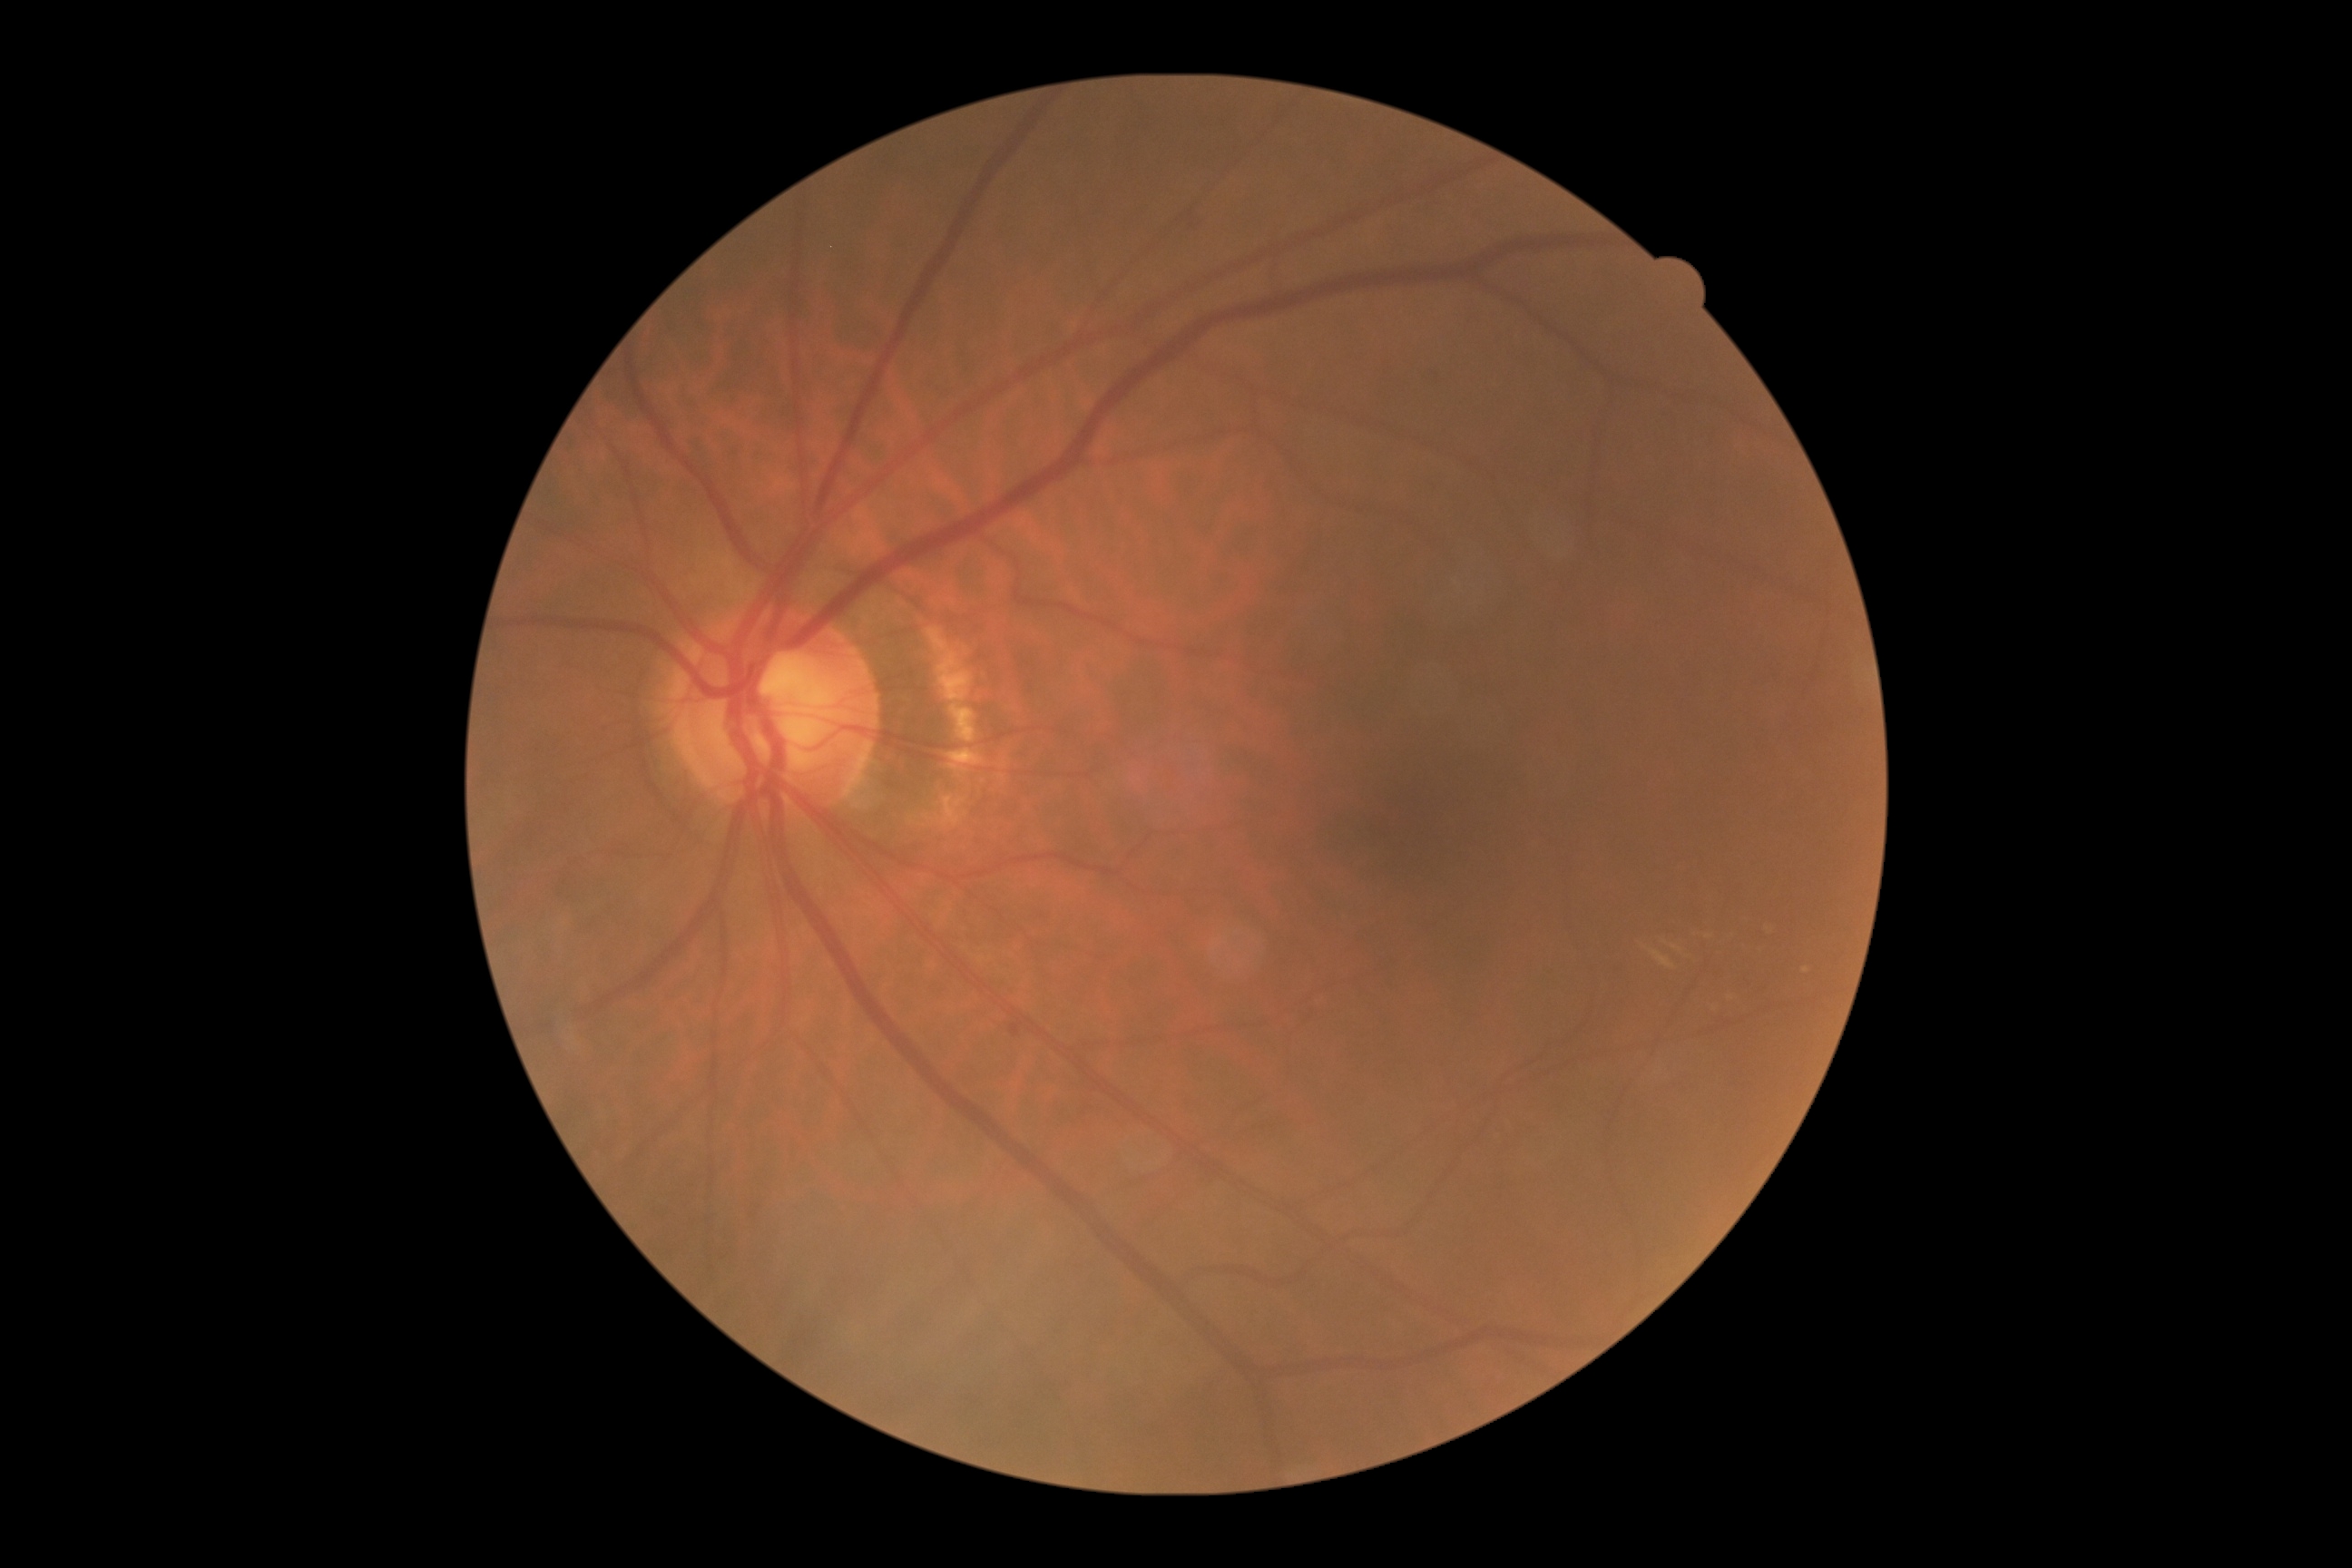 The retinopathy is classified as non-proliferative diabetic retinopathy. DR severity is moderate NPDR (grade 2).